848 by 848 pixels. Nonmydriatic fundus photograph. Diabetic retinopathy graded by the modified Davis classification. 45° field of view:
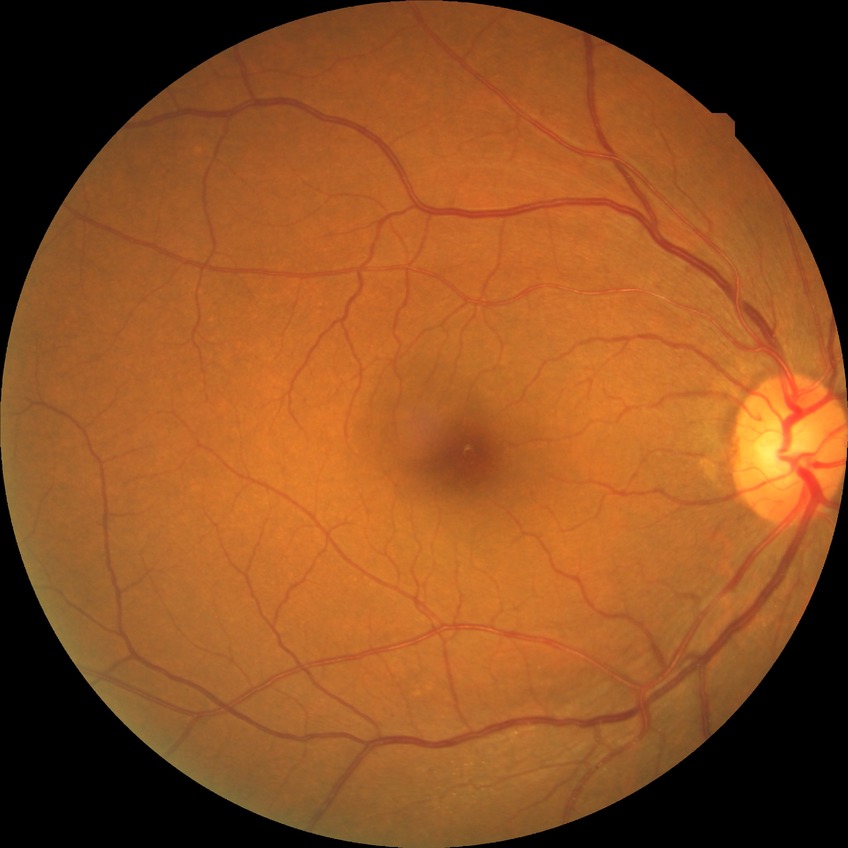 diabetic retinopathy (DR): NDR (no diabetic retinopathy)